Color fundus photograph.
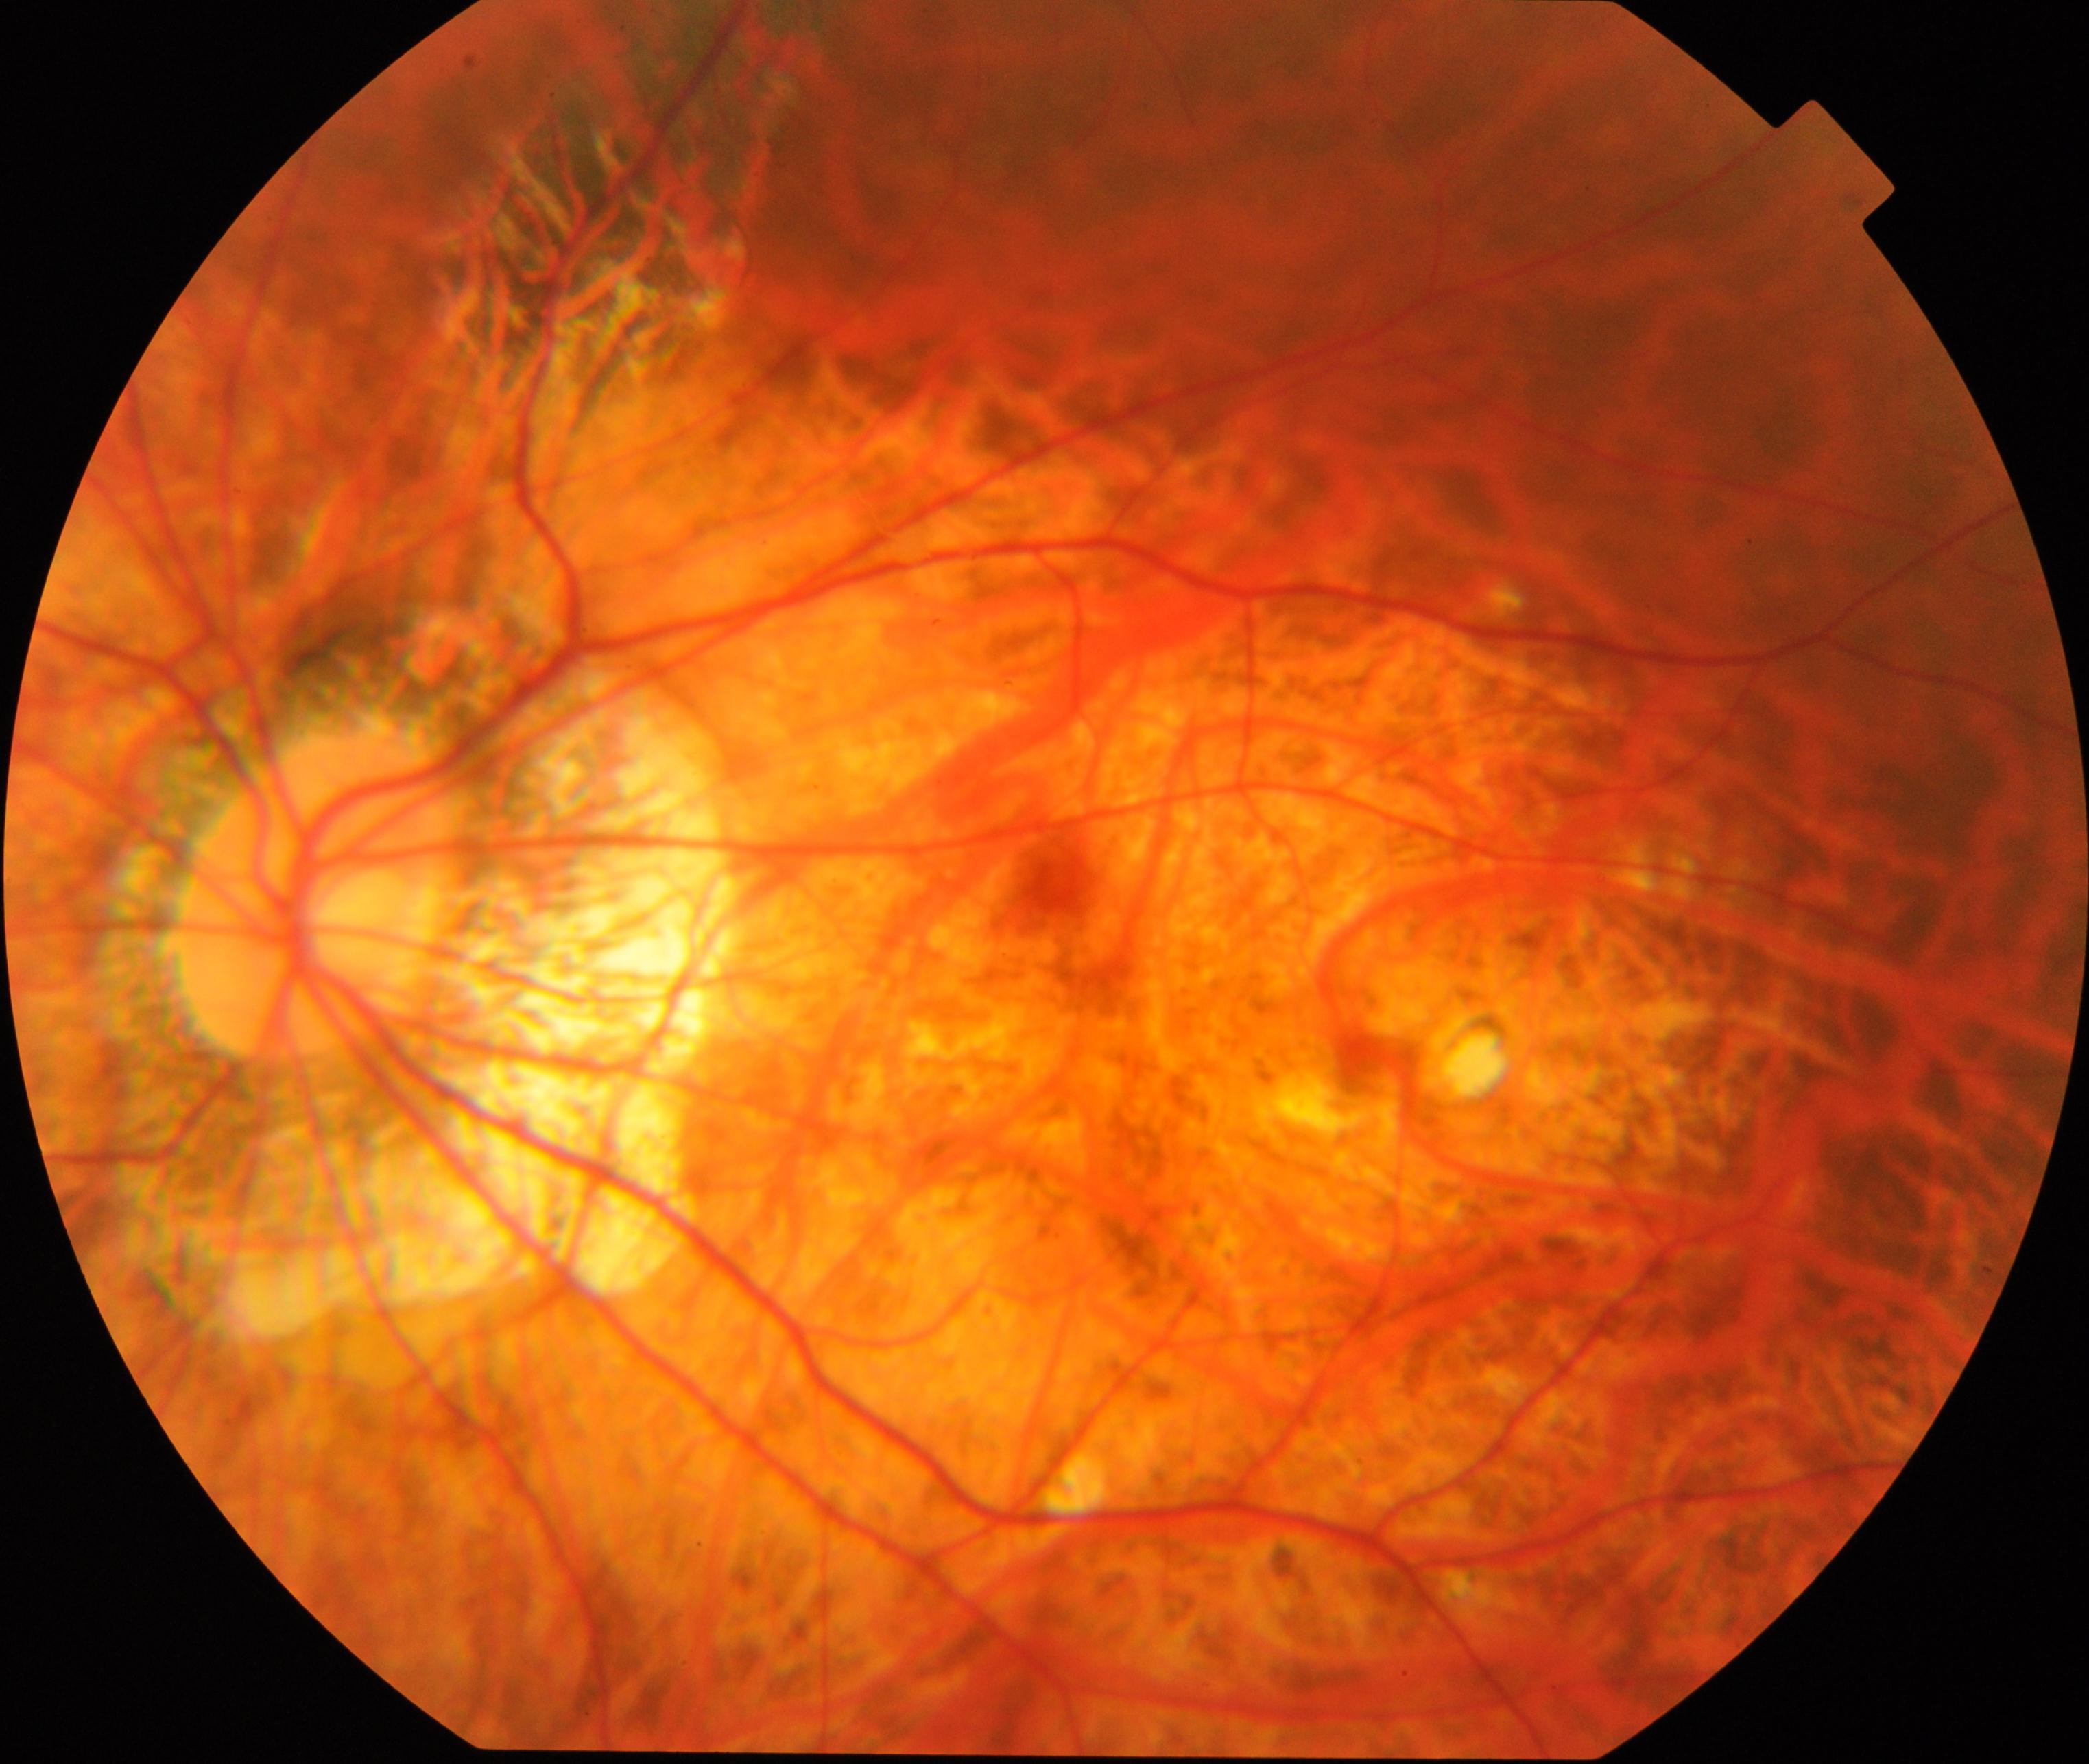 Consistent with pathological myopia.